Captured after pupil dilation
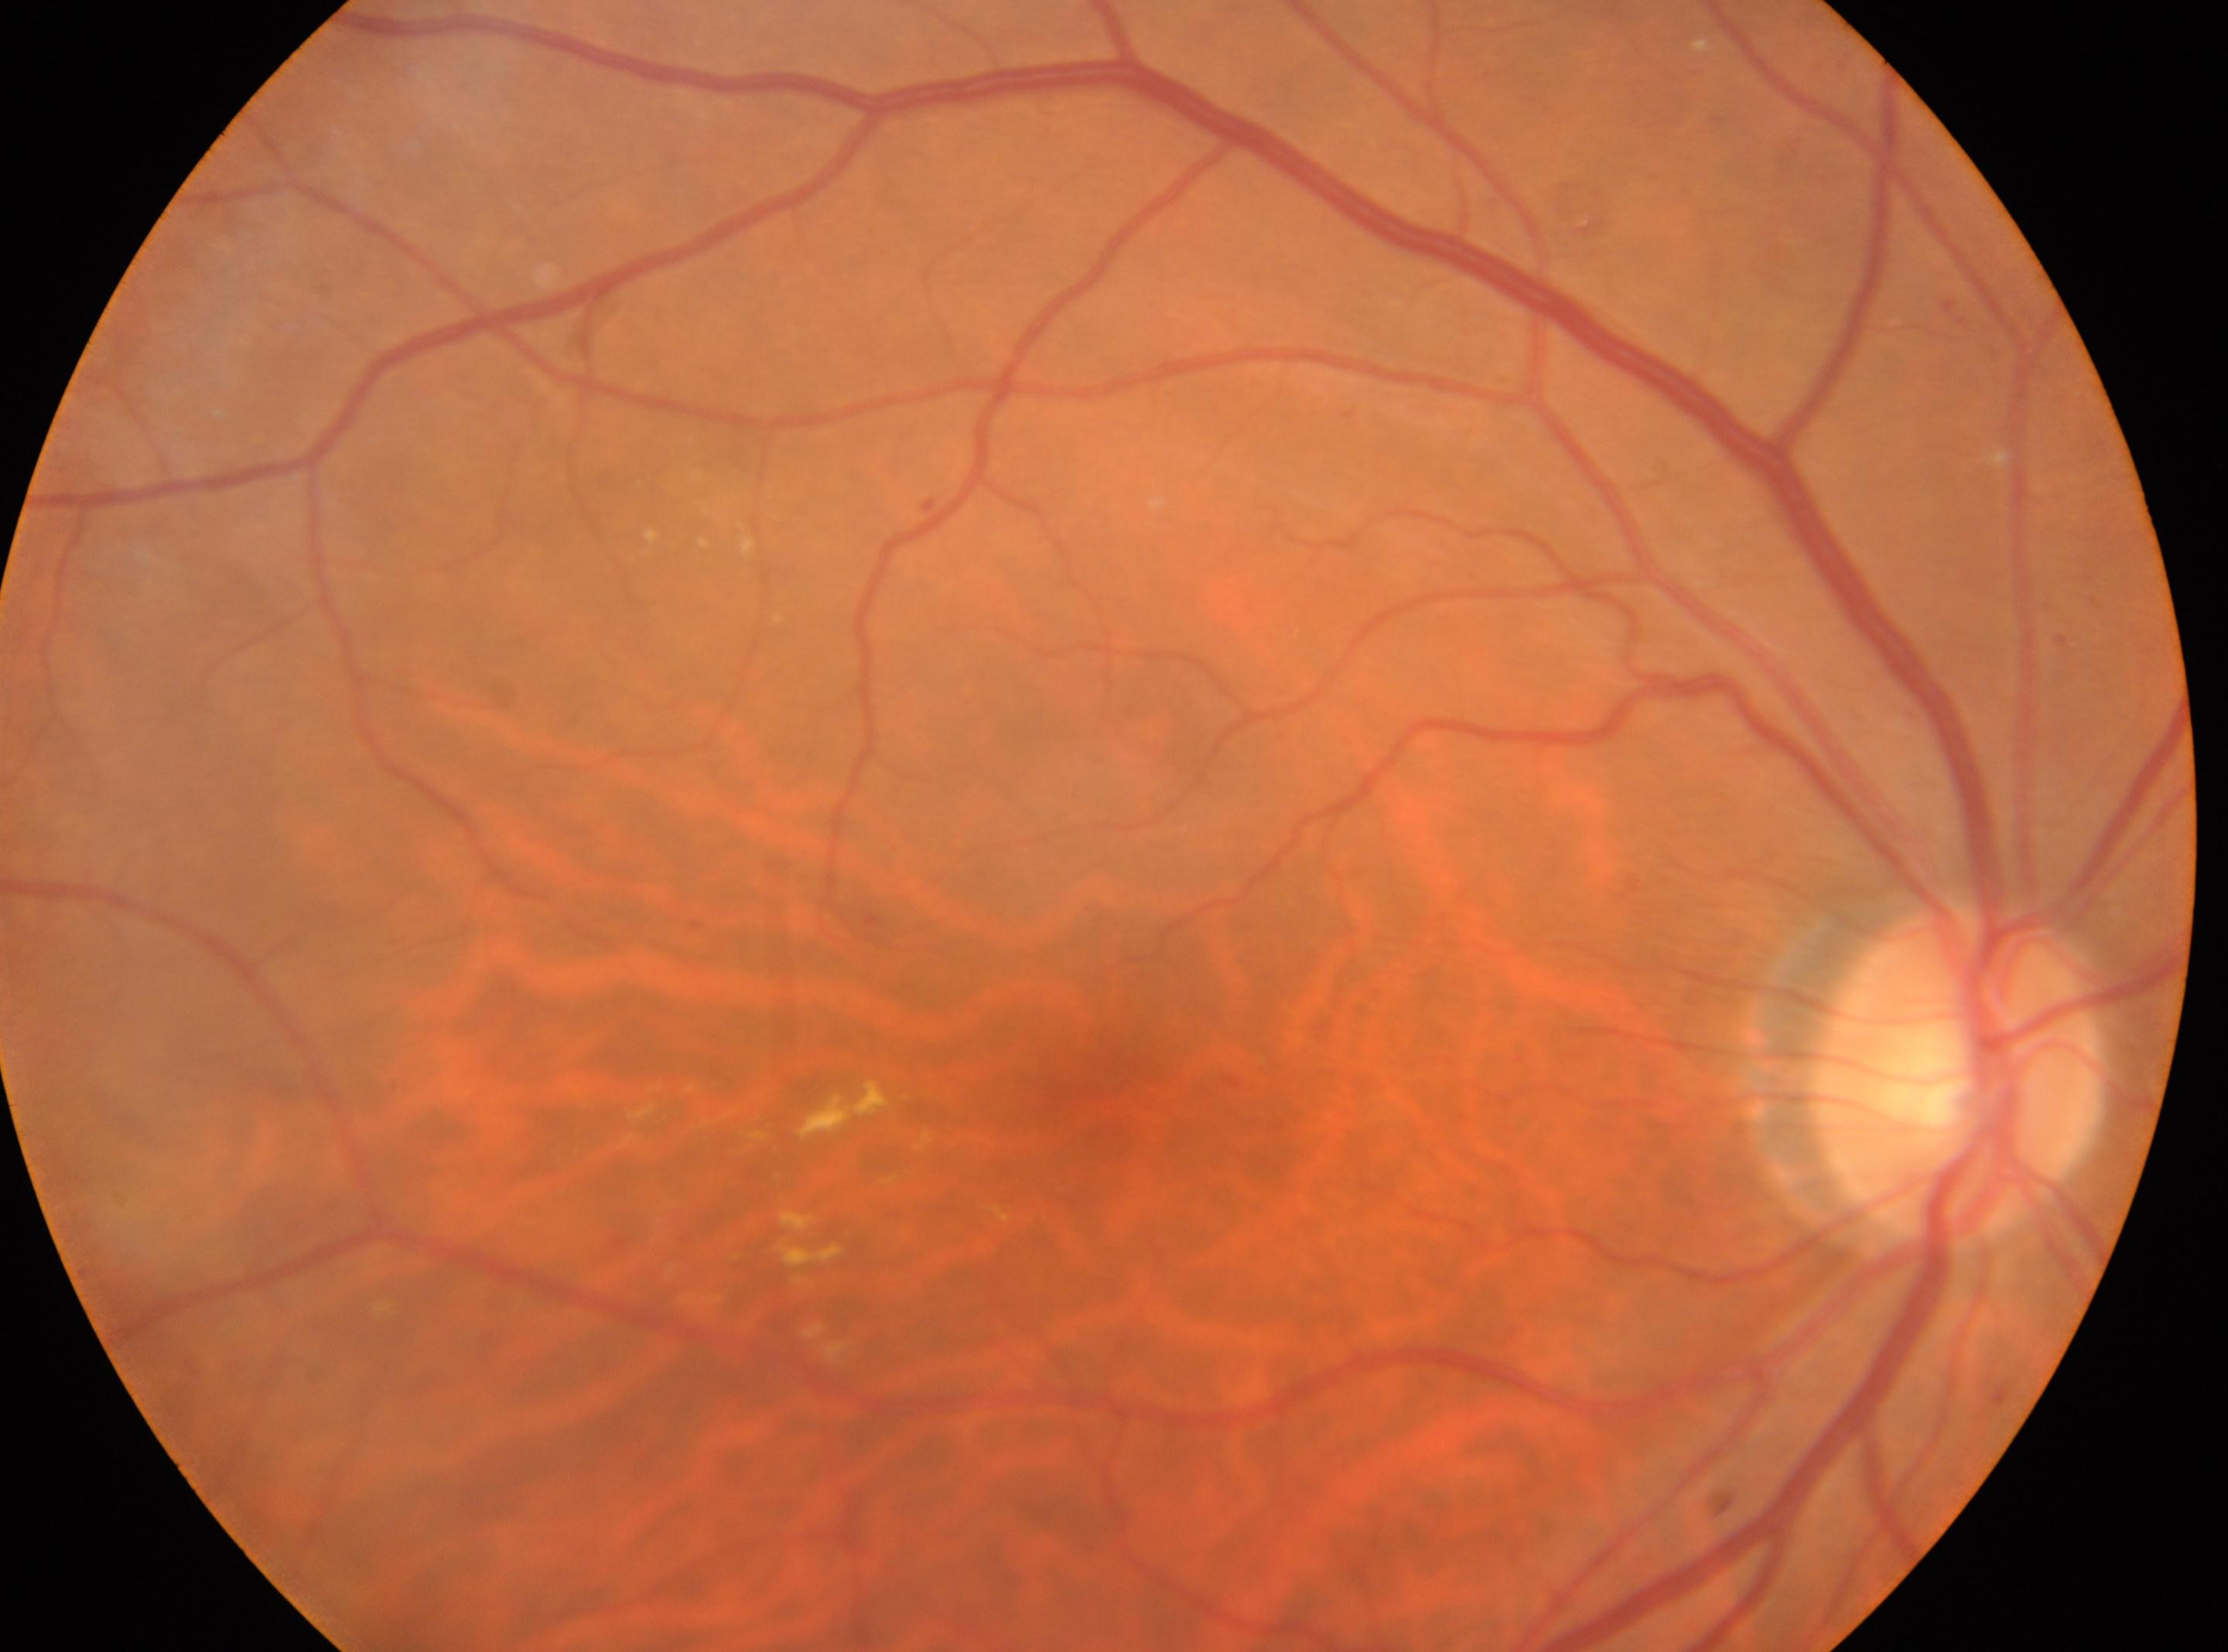 OD; macula center@(1119, 1098); disc center@(1957, 1073); diabetic retinopathy (DR)@2 — more than just microaneurysms but less than severe NPDR.